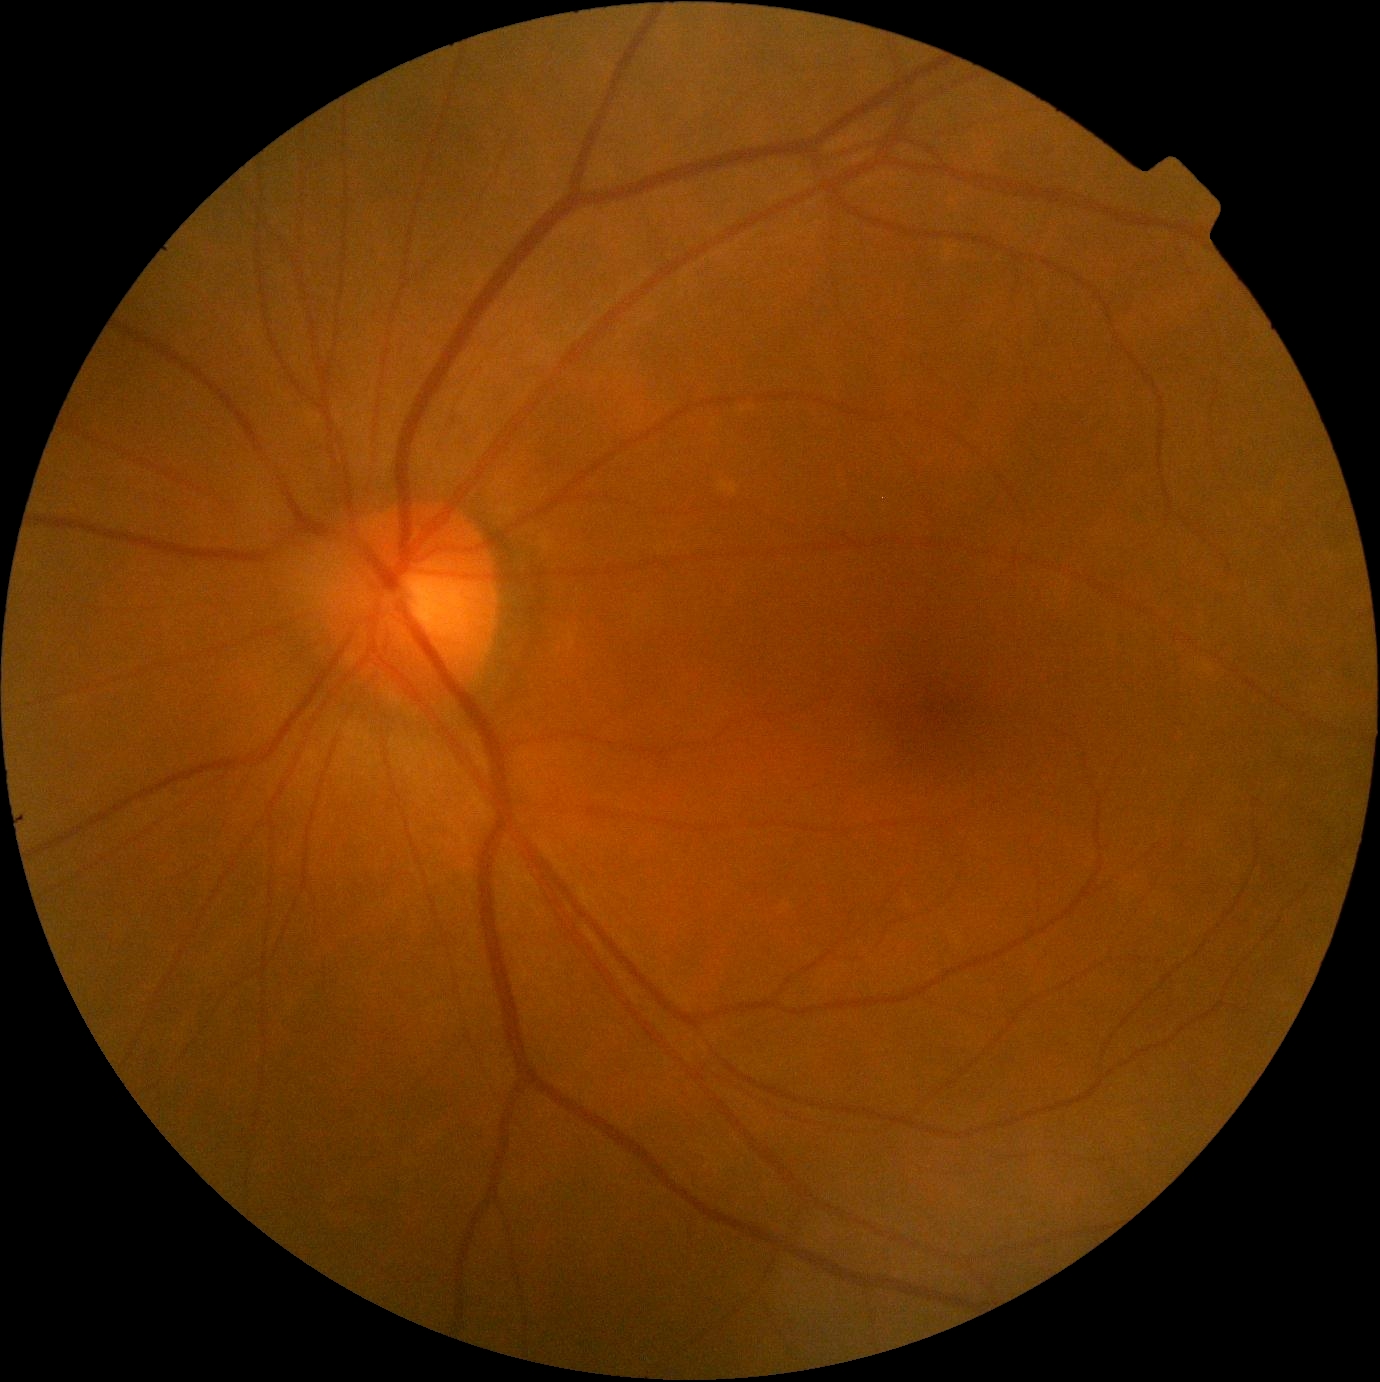 Diabetic retinopathy severity is grade 0 (no apparent retinopathy) — no visible signs of diabetic retinopathy. No diabetic retinal disease findings.